Wide-field contact fundus photograph of an infant:
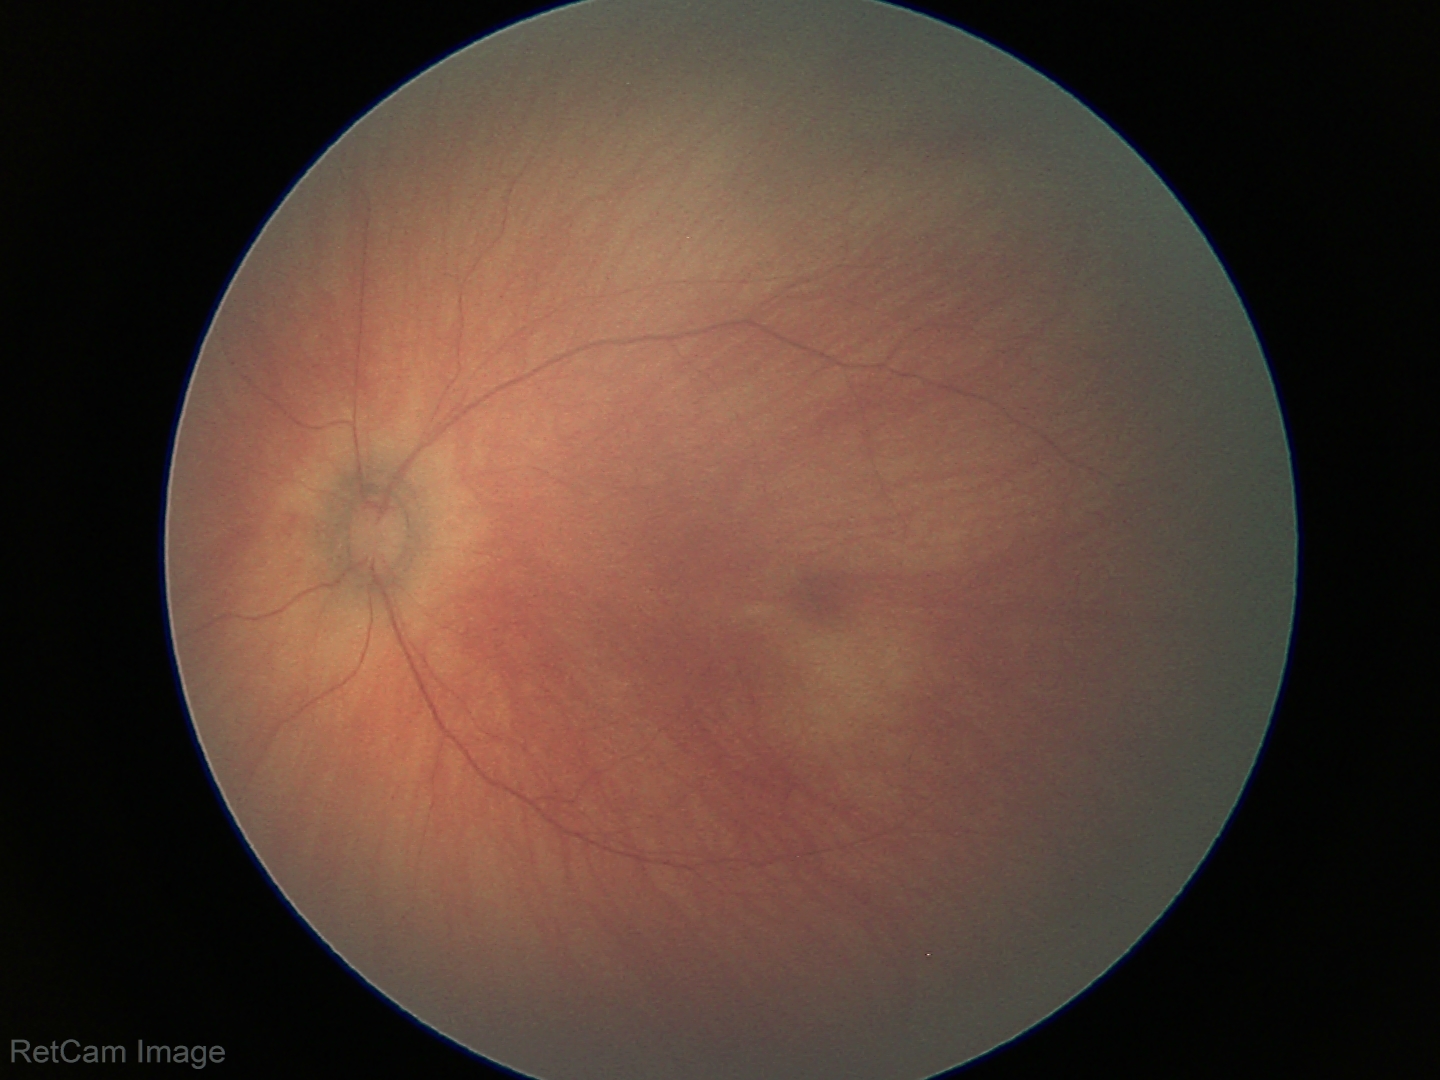
No retinal pathology identified on screening.